Pupil-dilated:
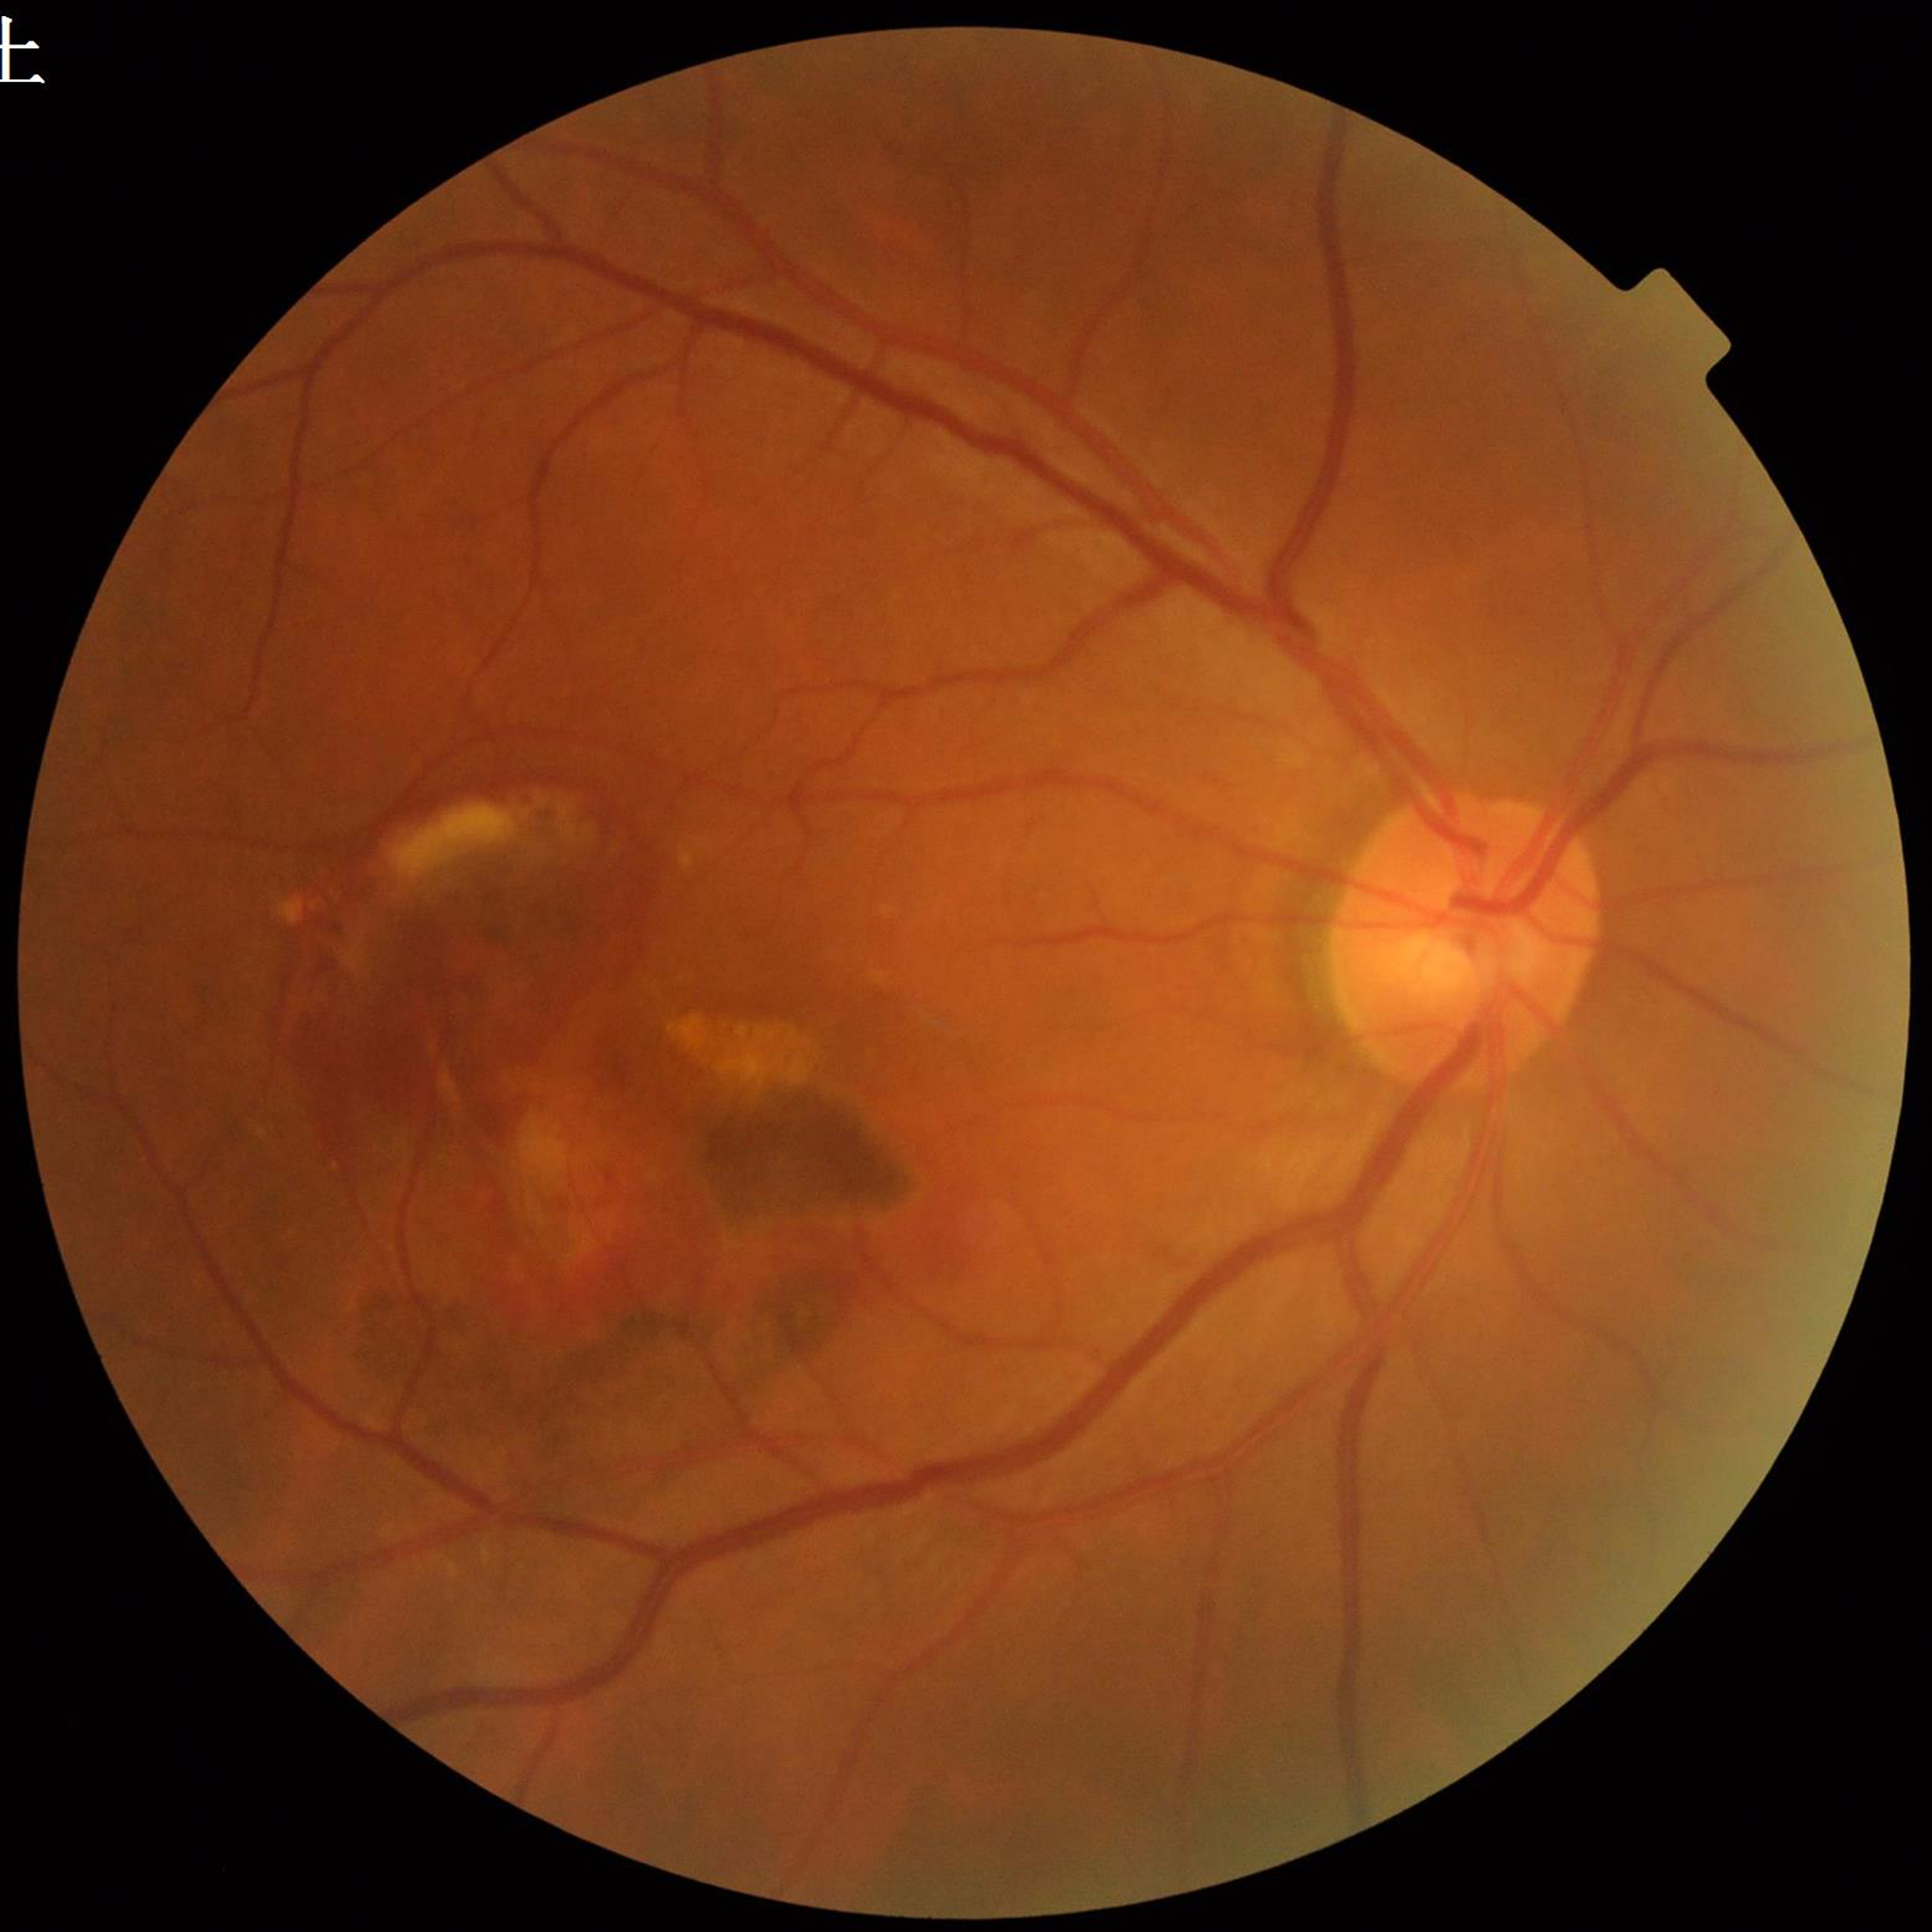
Diagnosis = AMD.